Retinal fundus photograph: 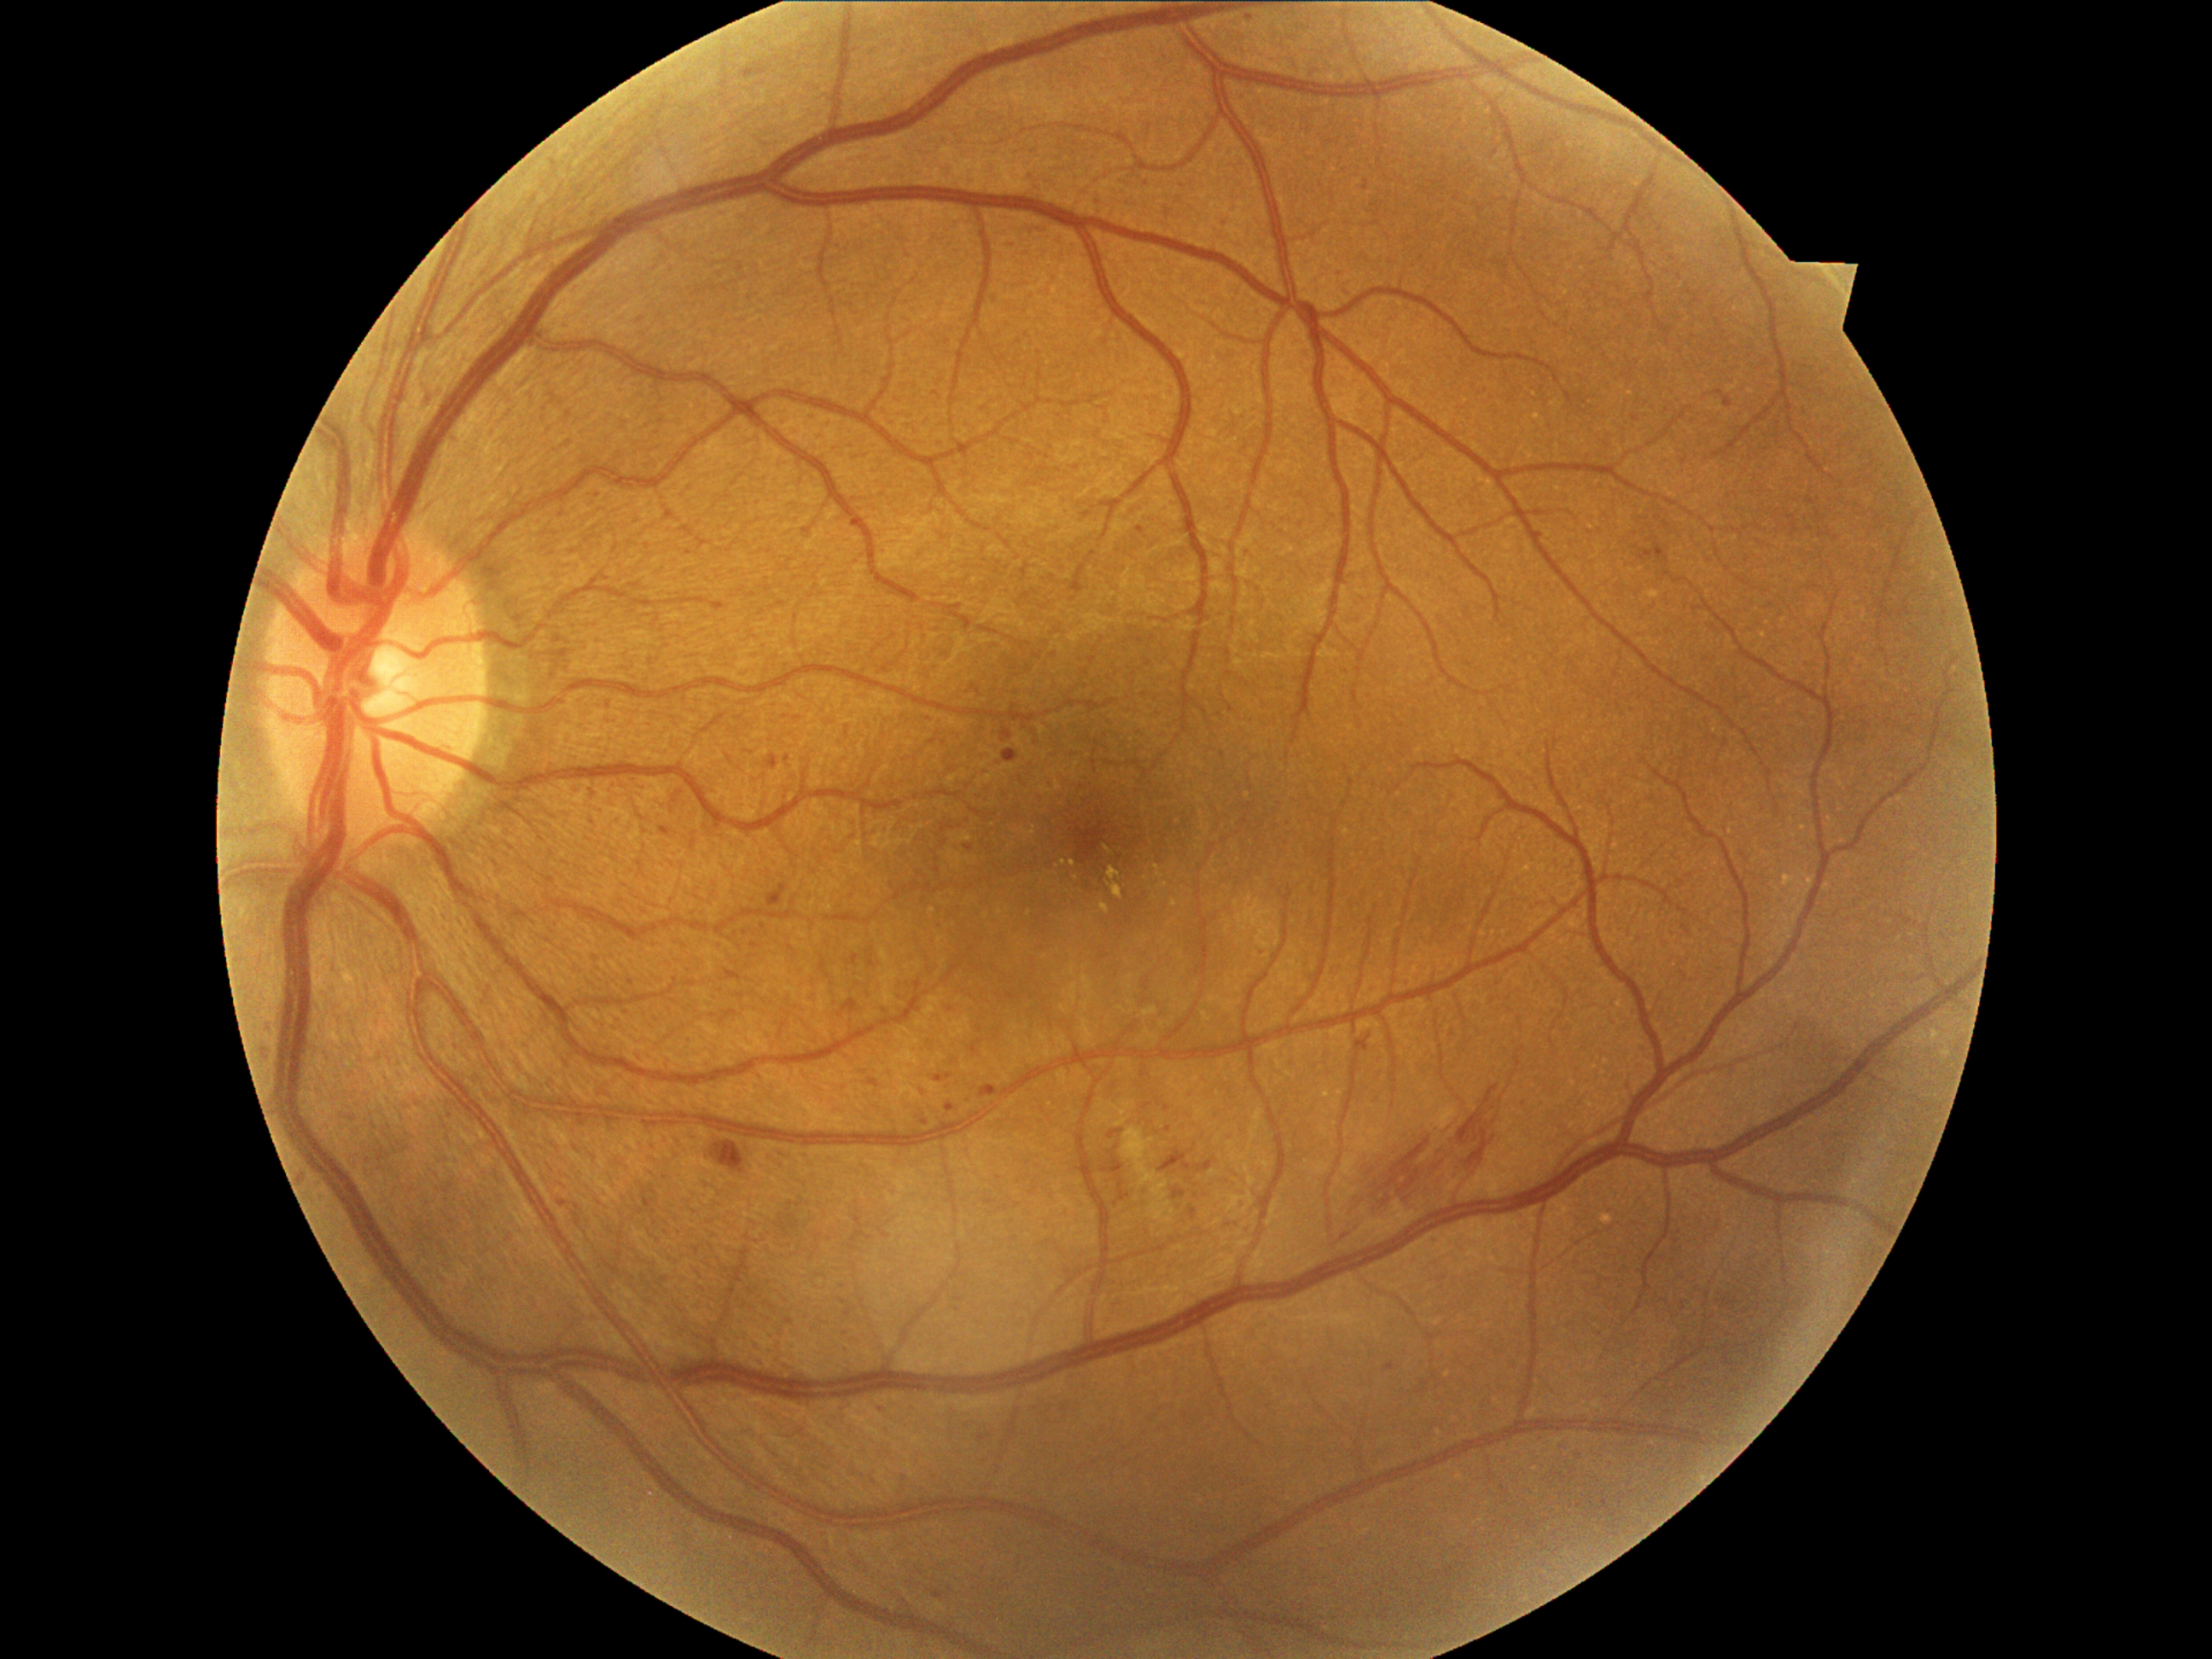
{"partial":true,"dr_grade":2,"lesions":{"ma":[[934,1074,945,1081],[851,518,858,527],[1165,1127,1173,1134],[1544,535,1549,545],[742,64,771,79],[661,822,672,837],[1197,1160,1214,1172],[1385,1363,1395,1371],[965,846,974,851],[946,1103,958,1114],[1119,1179,1131,1202]],"ma_small":[[924,1124],[1563,1448],[1250,18],[949,1076]]}}